Graded on the modified Davis scale — 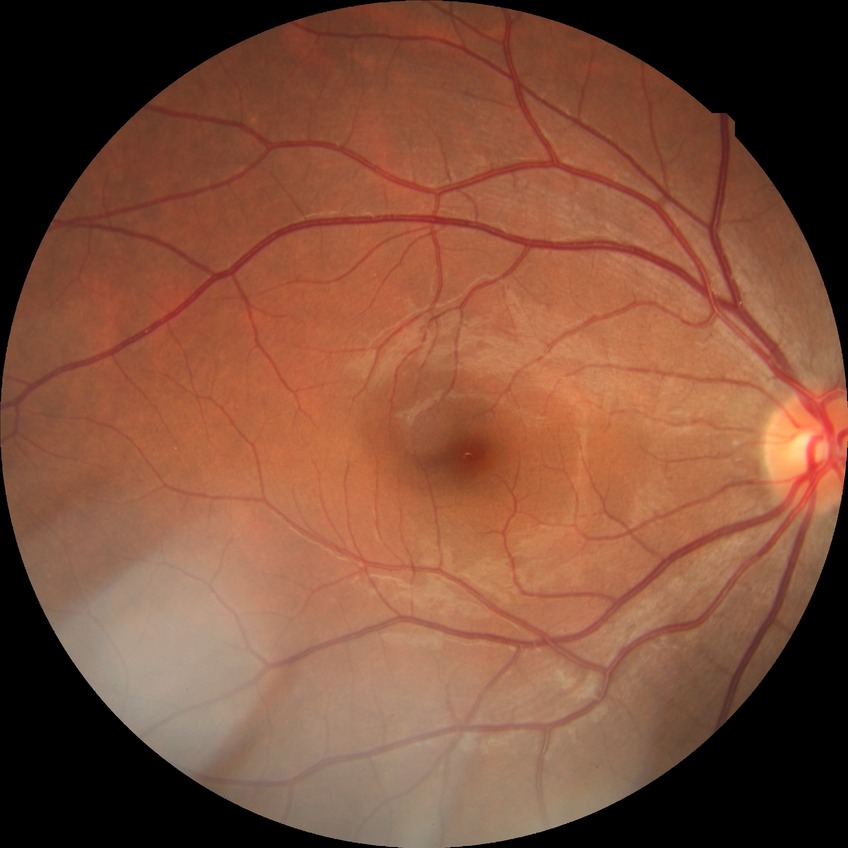 diabetic retinopathy stage@no diabetic retinopathy.